Dilated-pupil acquisition — 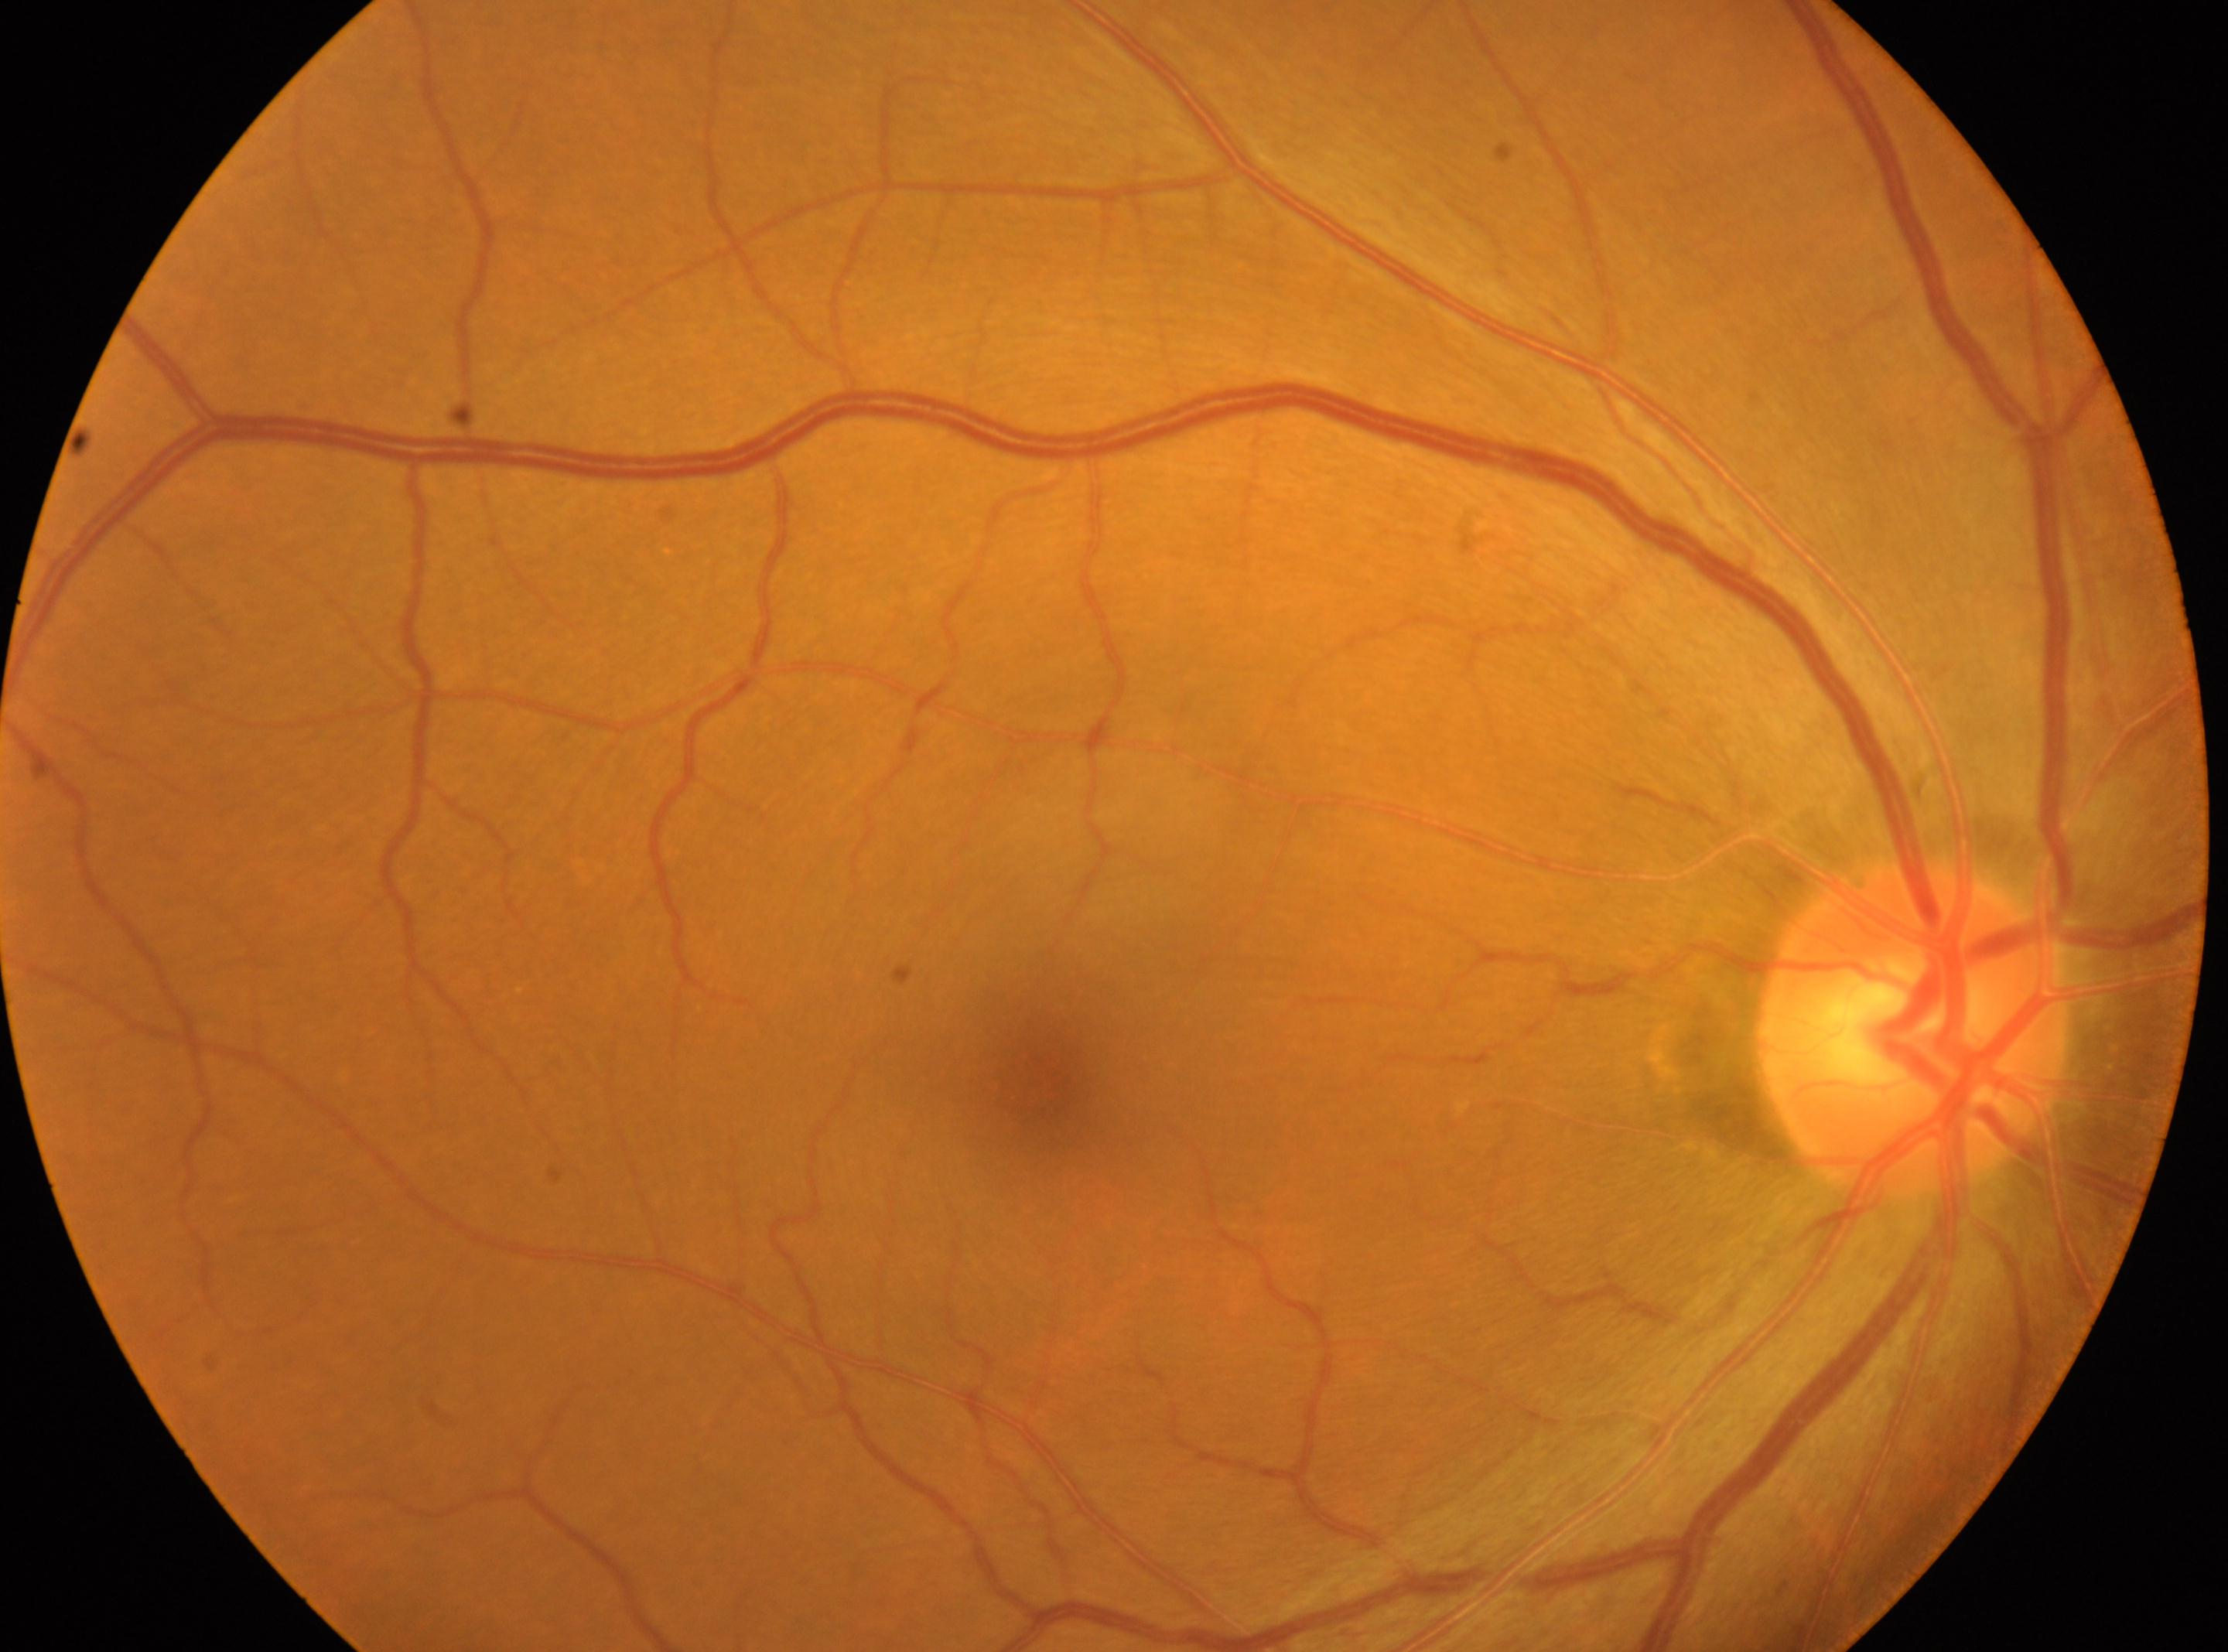   optic_disc: 1911, 1029
  eye: OD
  fovea: 1047, 1073
  dr_grade: 0